Acquired with a Nidek AFC-330:
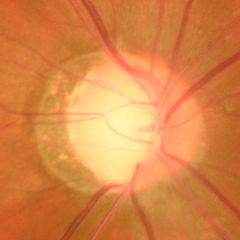 Glaucoma assessment: early glaucoma.